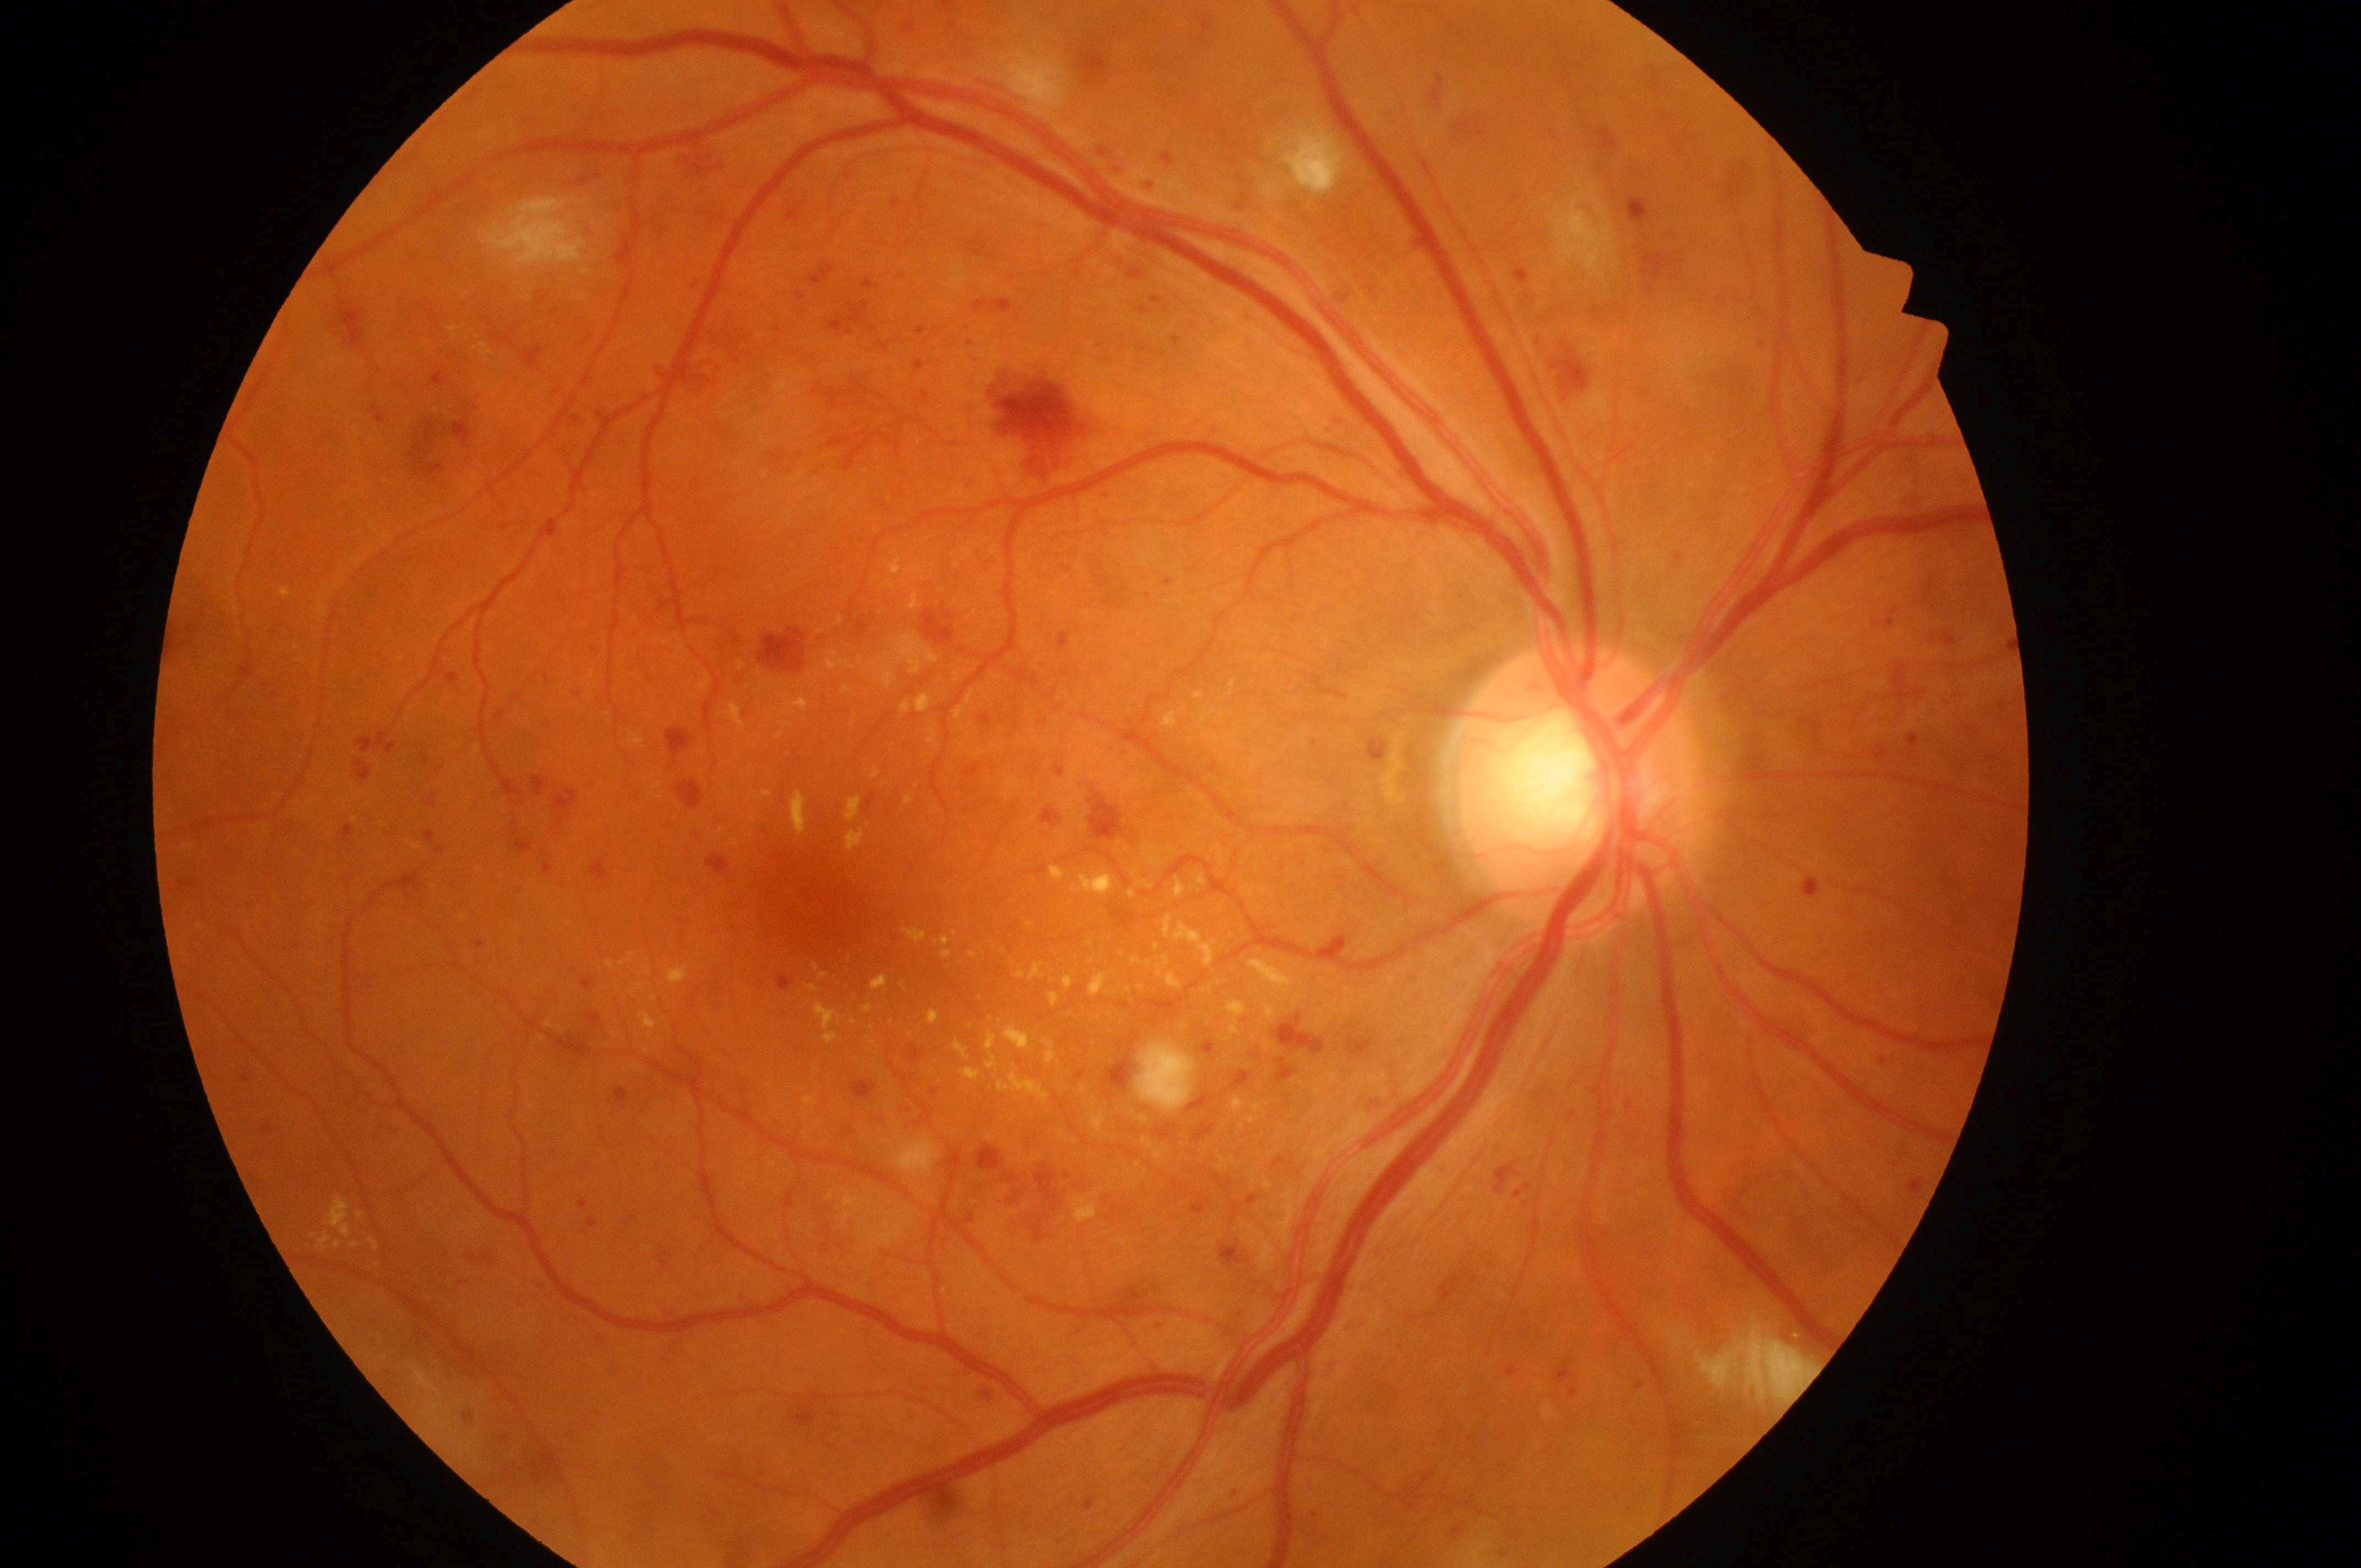

Macular edema risk is 2.
Eye: the right eye.
The optic disk is at (1570,793).
Diabetic retinopathy grade is 4/4.
Foveal center located at (808,897).